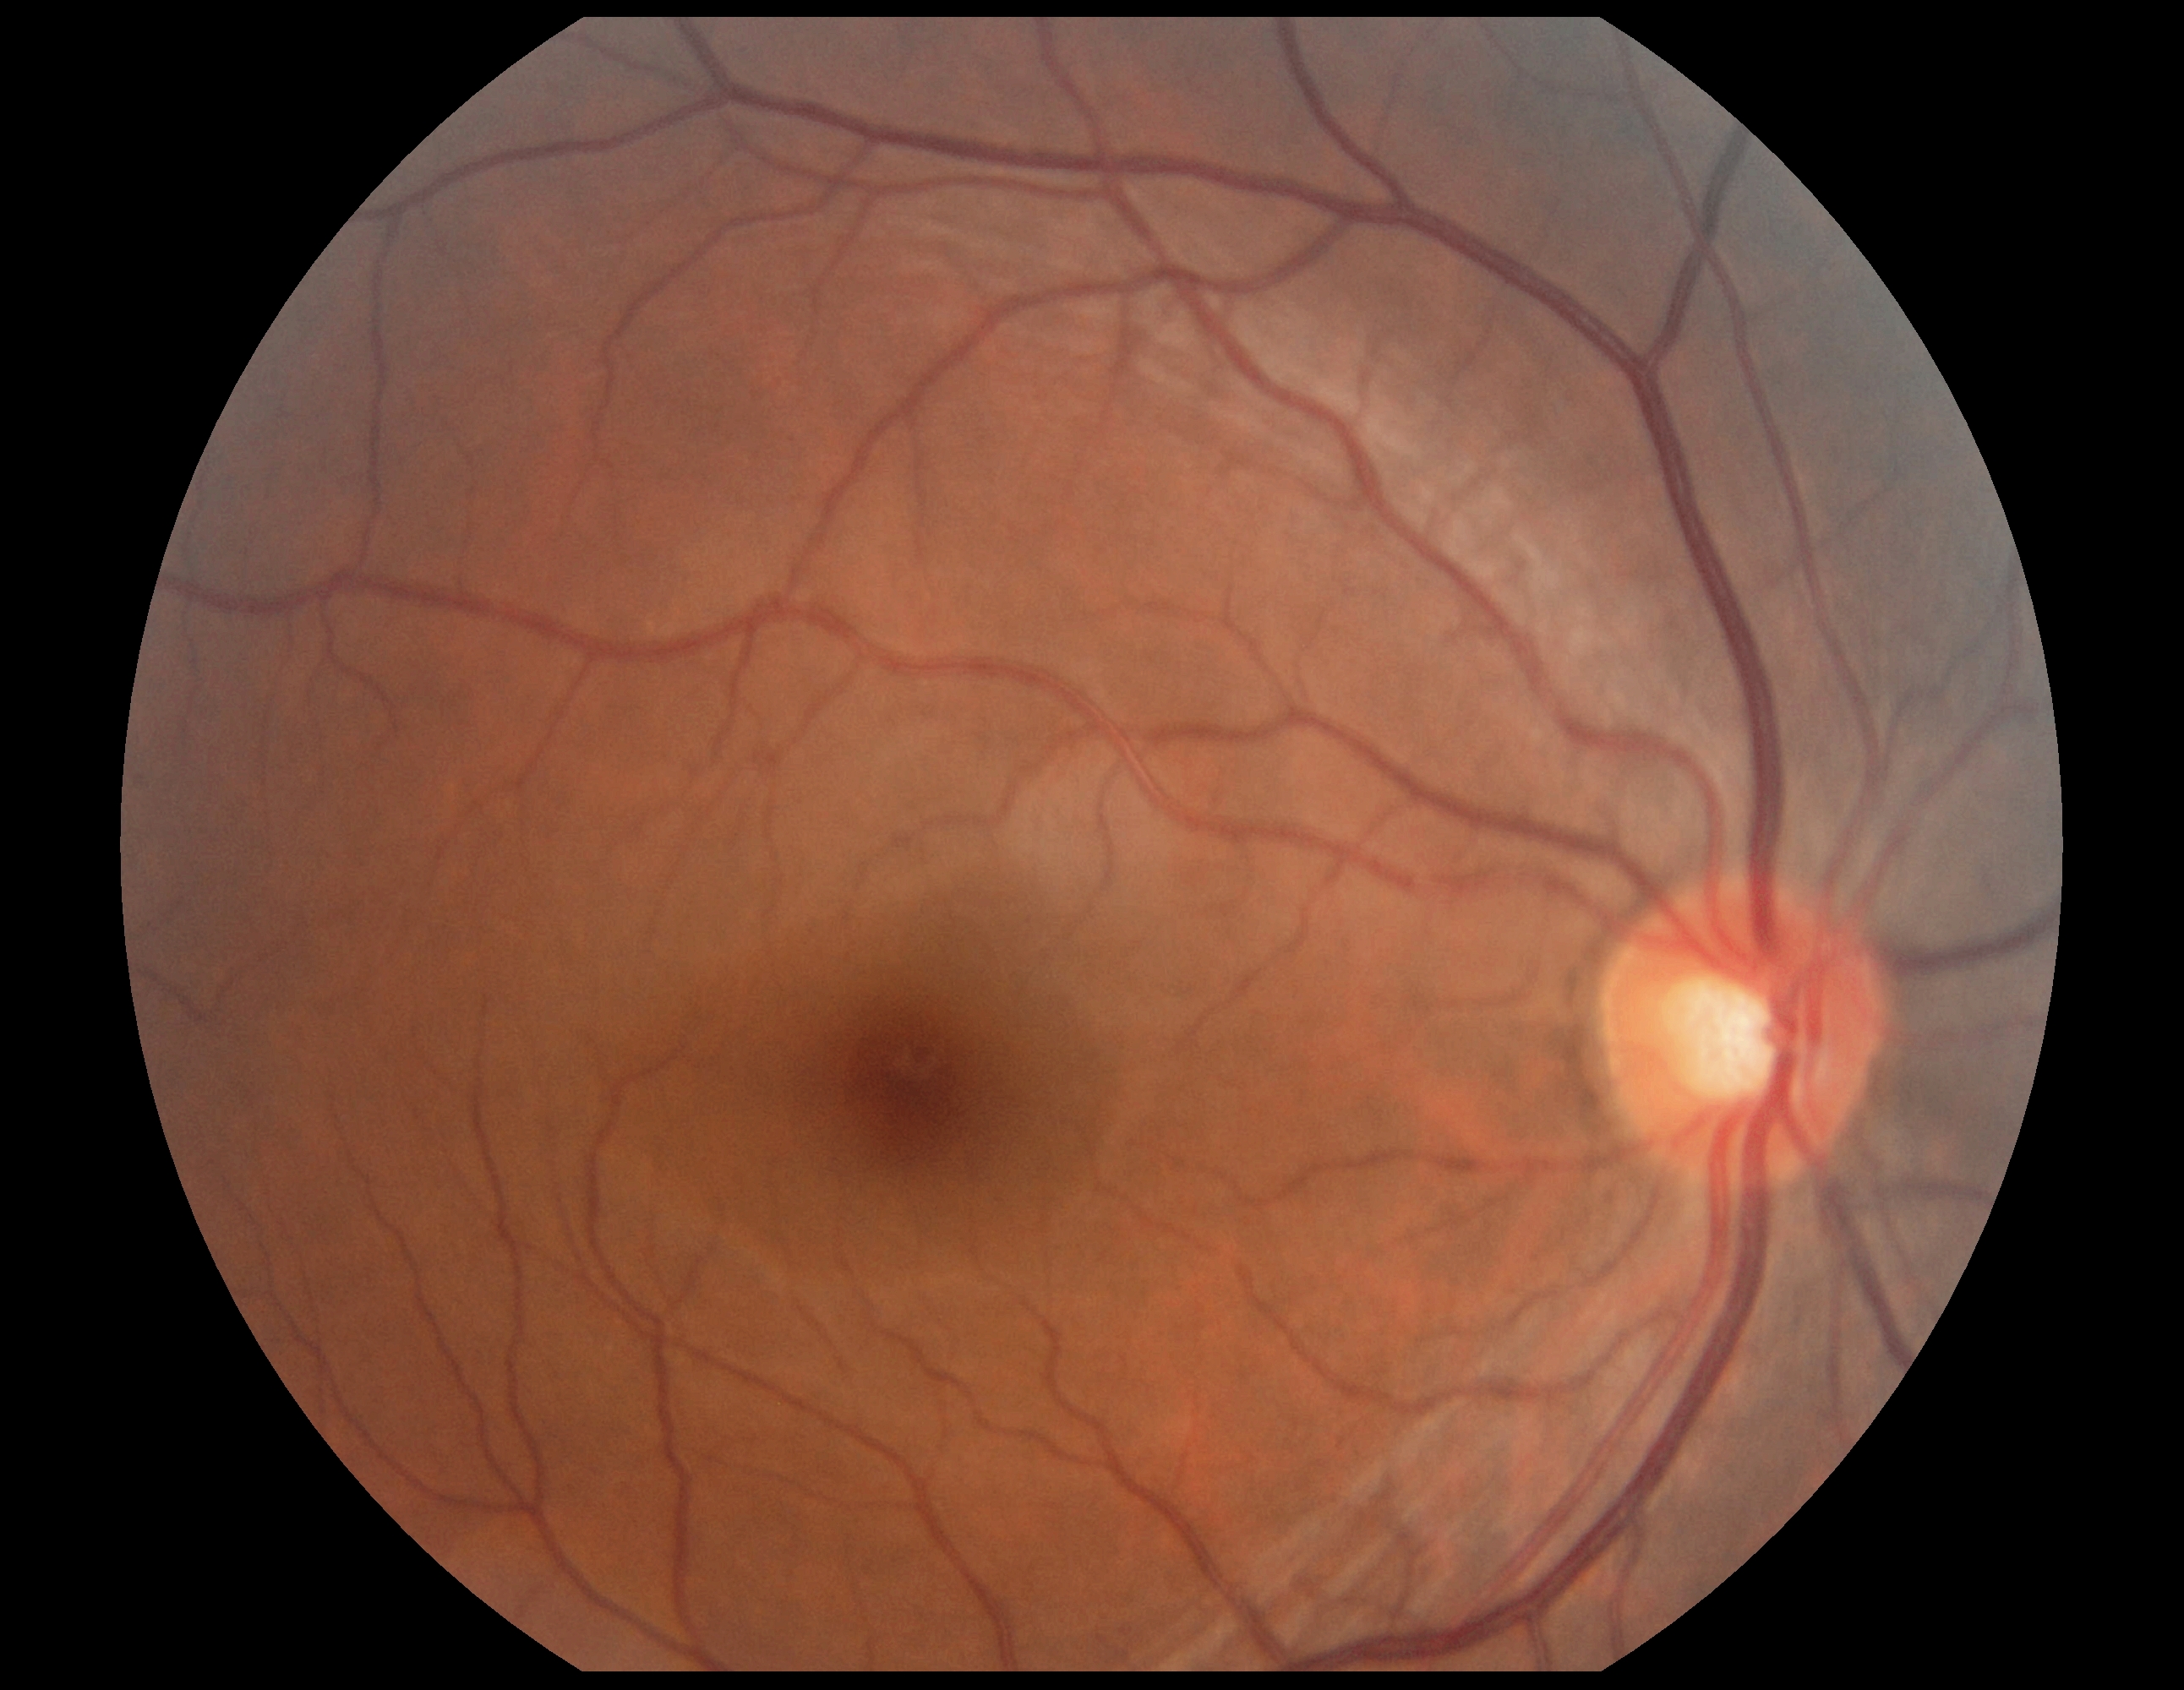 Diabetic retinopathy severity is 0/4.